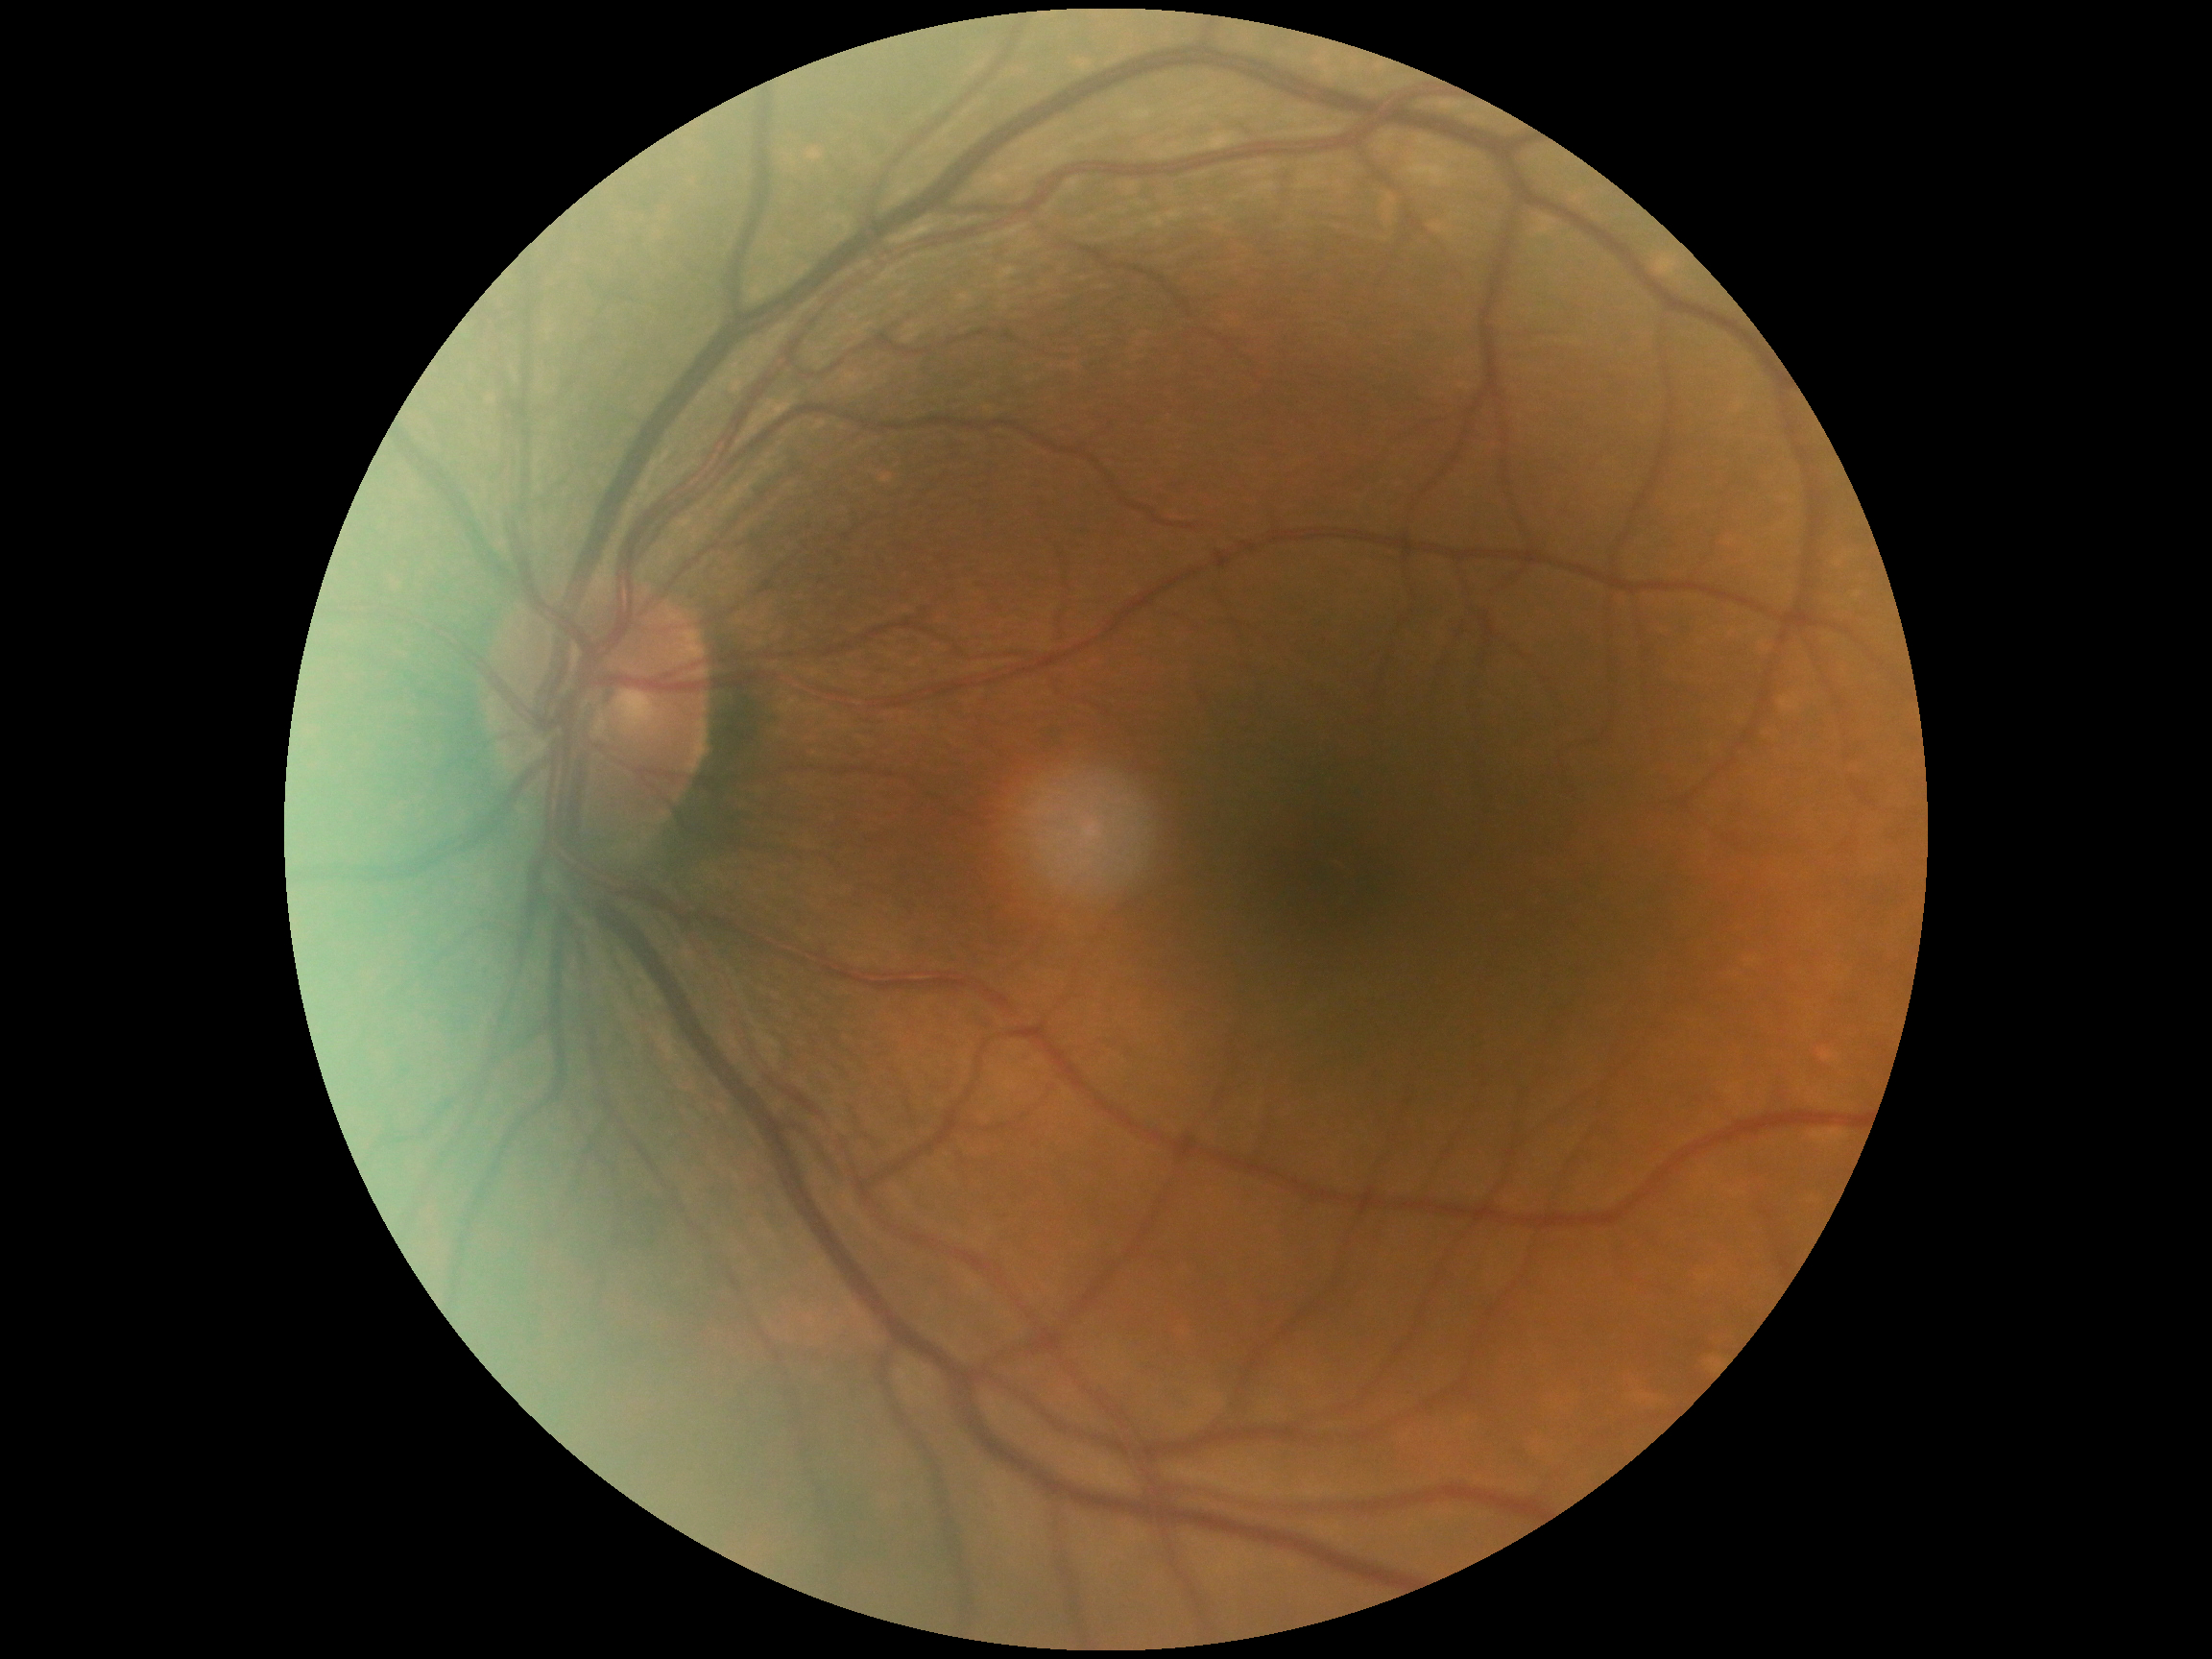 Diabetic retinopathy (DR) is 0.